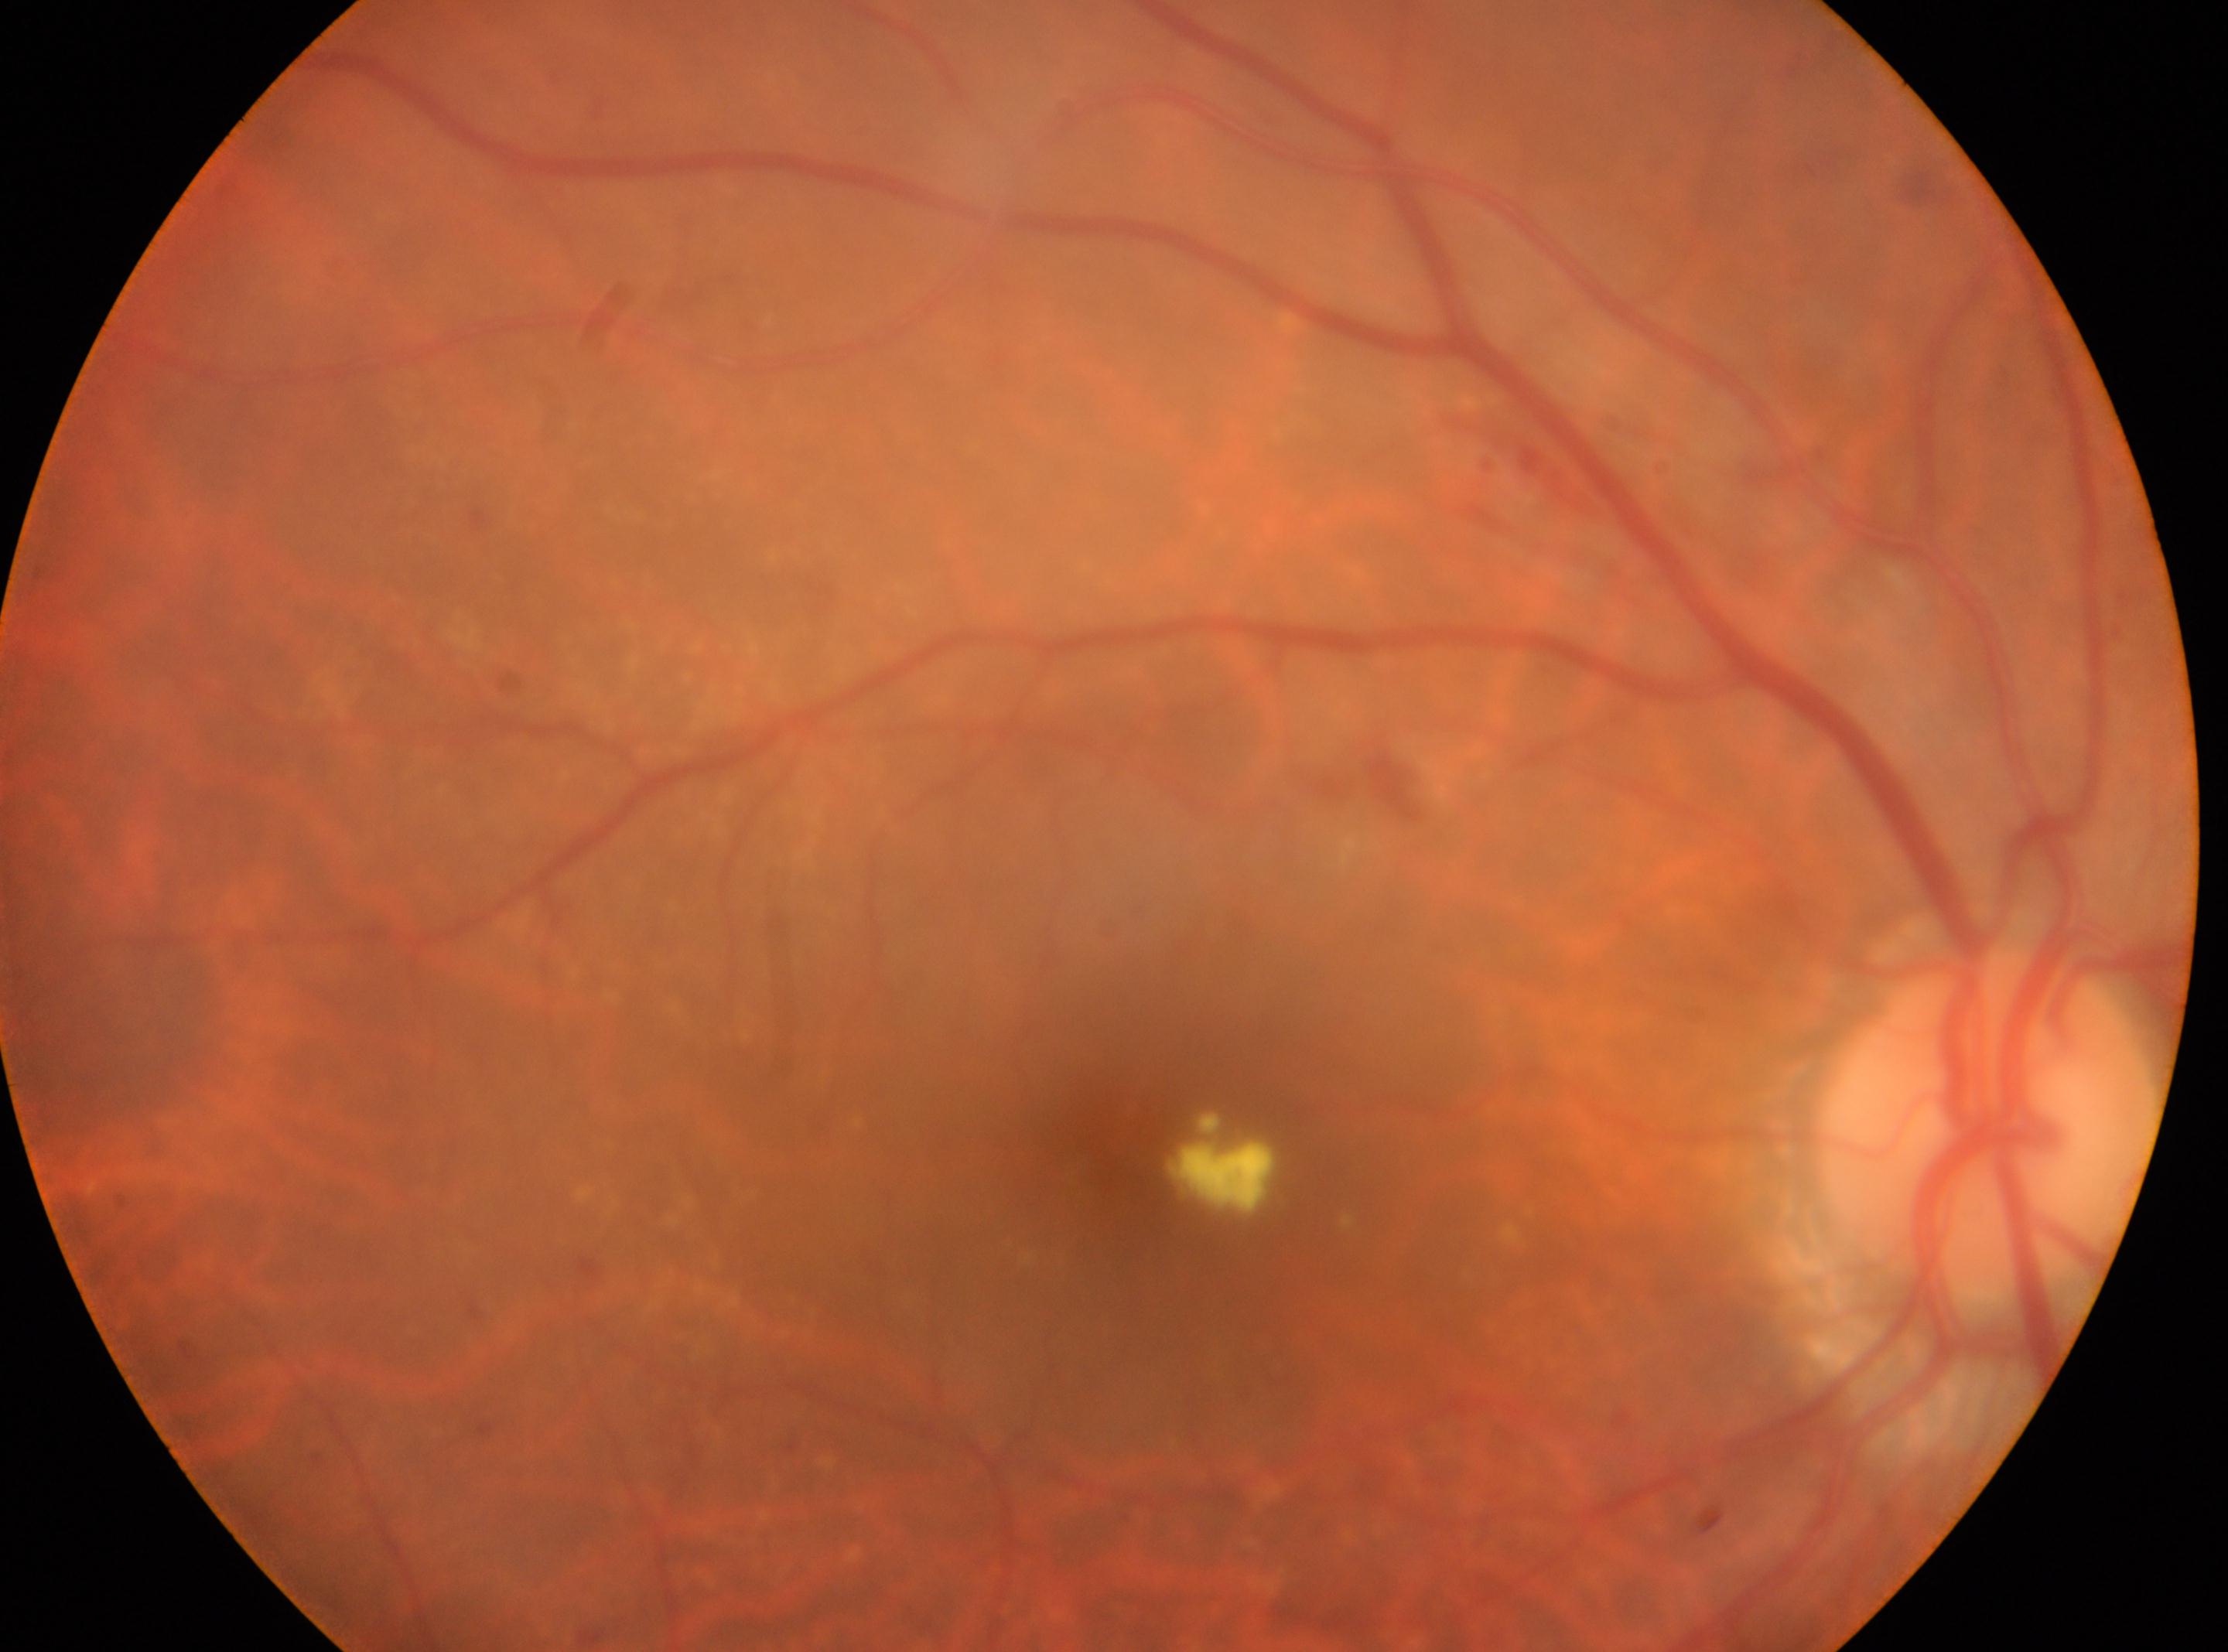
ONH: (x: 1984, y: 1125). This is the oculus dexter. Diabetic retinopathy grade: 2 (moderate NPDR) — more than just microaneurysms but less than severe NPDR. The macular center is at (x: 1171, y: 1172).